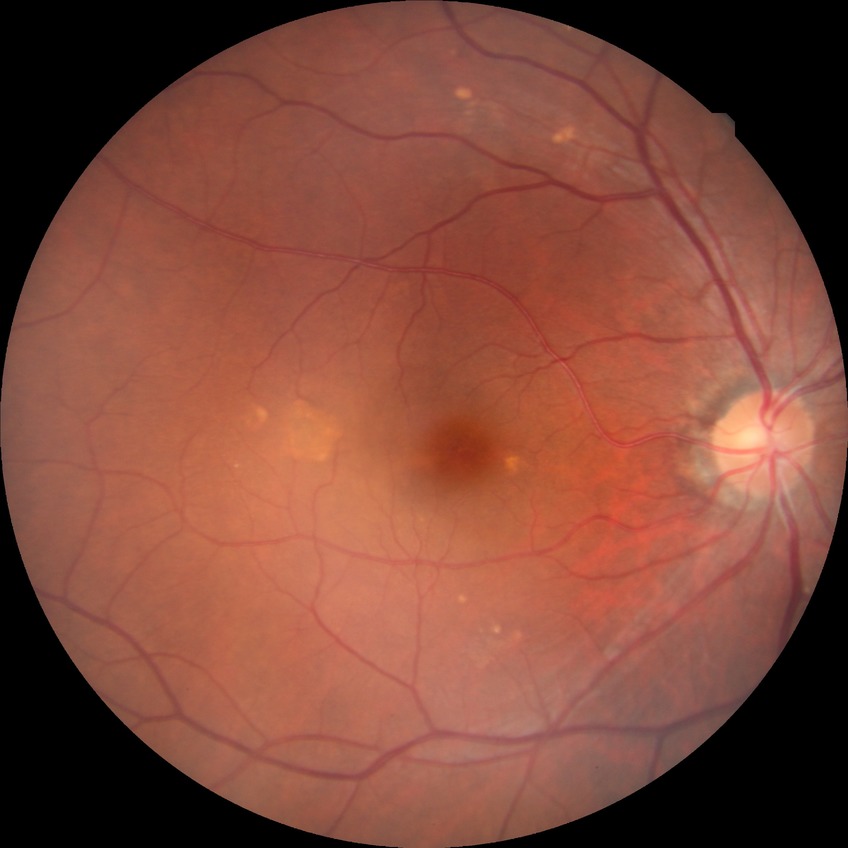
Retinopathy stage is no diabetic retinopathy.